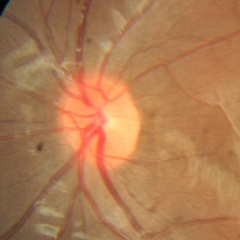
Q: What stage of glaucoma is present?
A: No — no glaucomatous optic neuropathy.